45° field of view, NIDEK AFC-230 fundus camera — 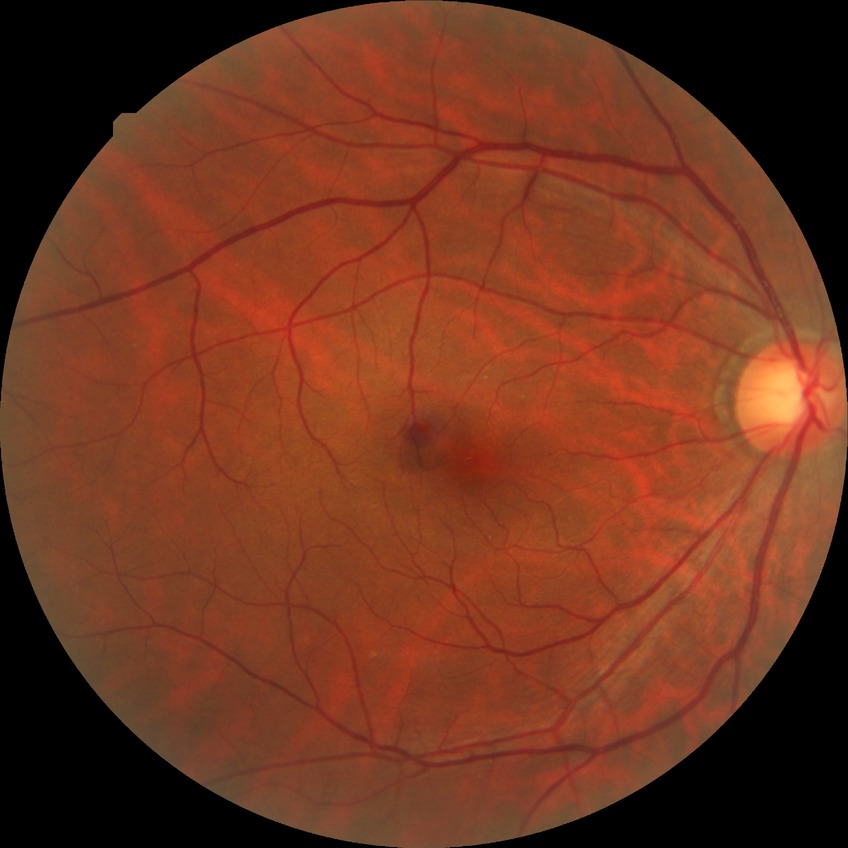

Assessment:
* diabetic retinopathy (DR): SDR (simple diabetic retinopathy)
* DR class: non-proliferative diabetic retinopathy